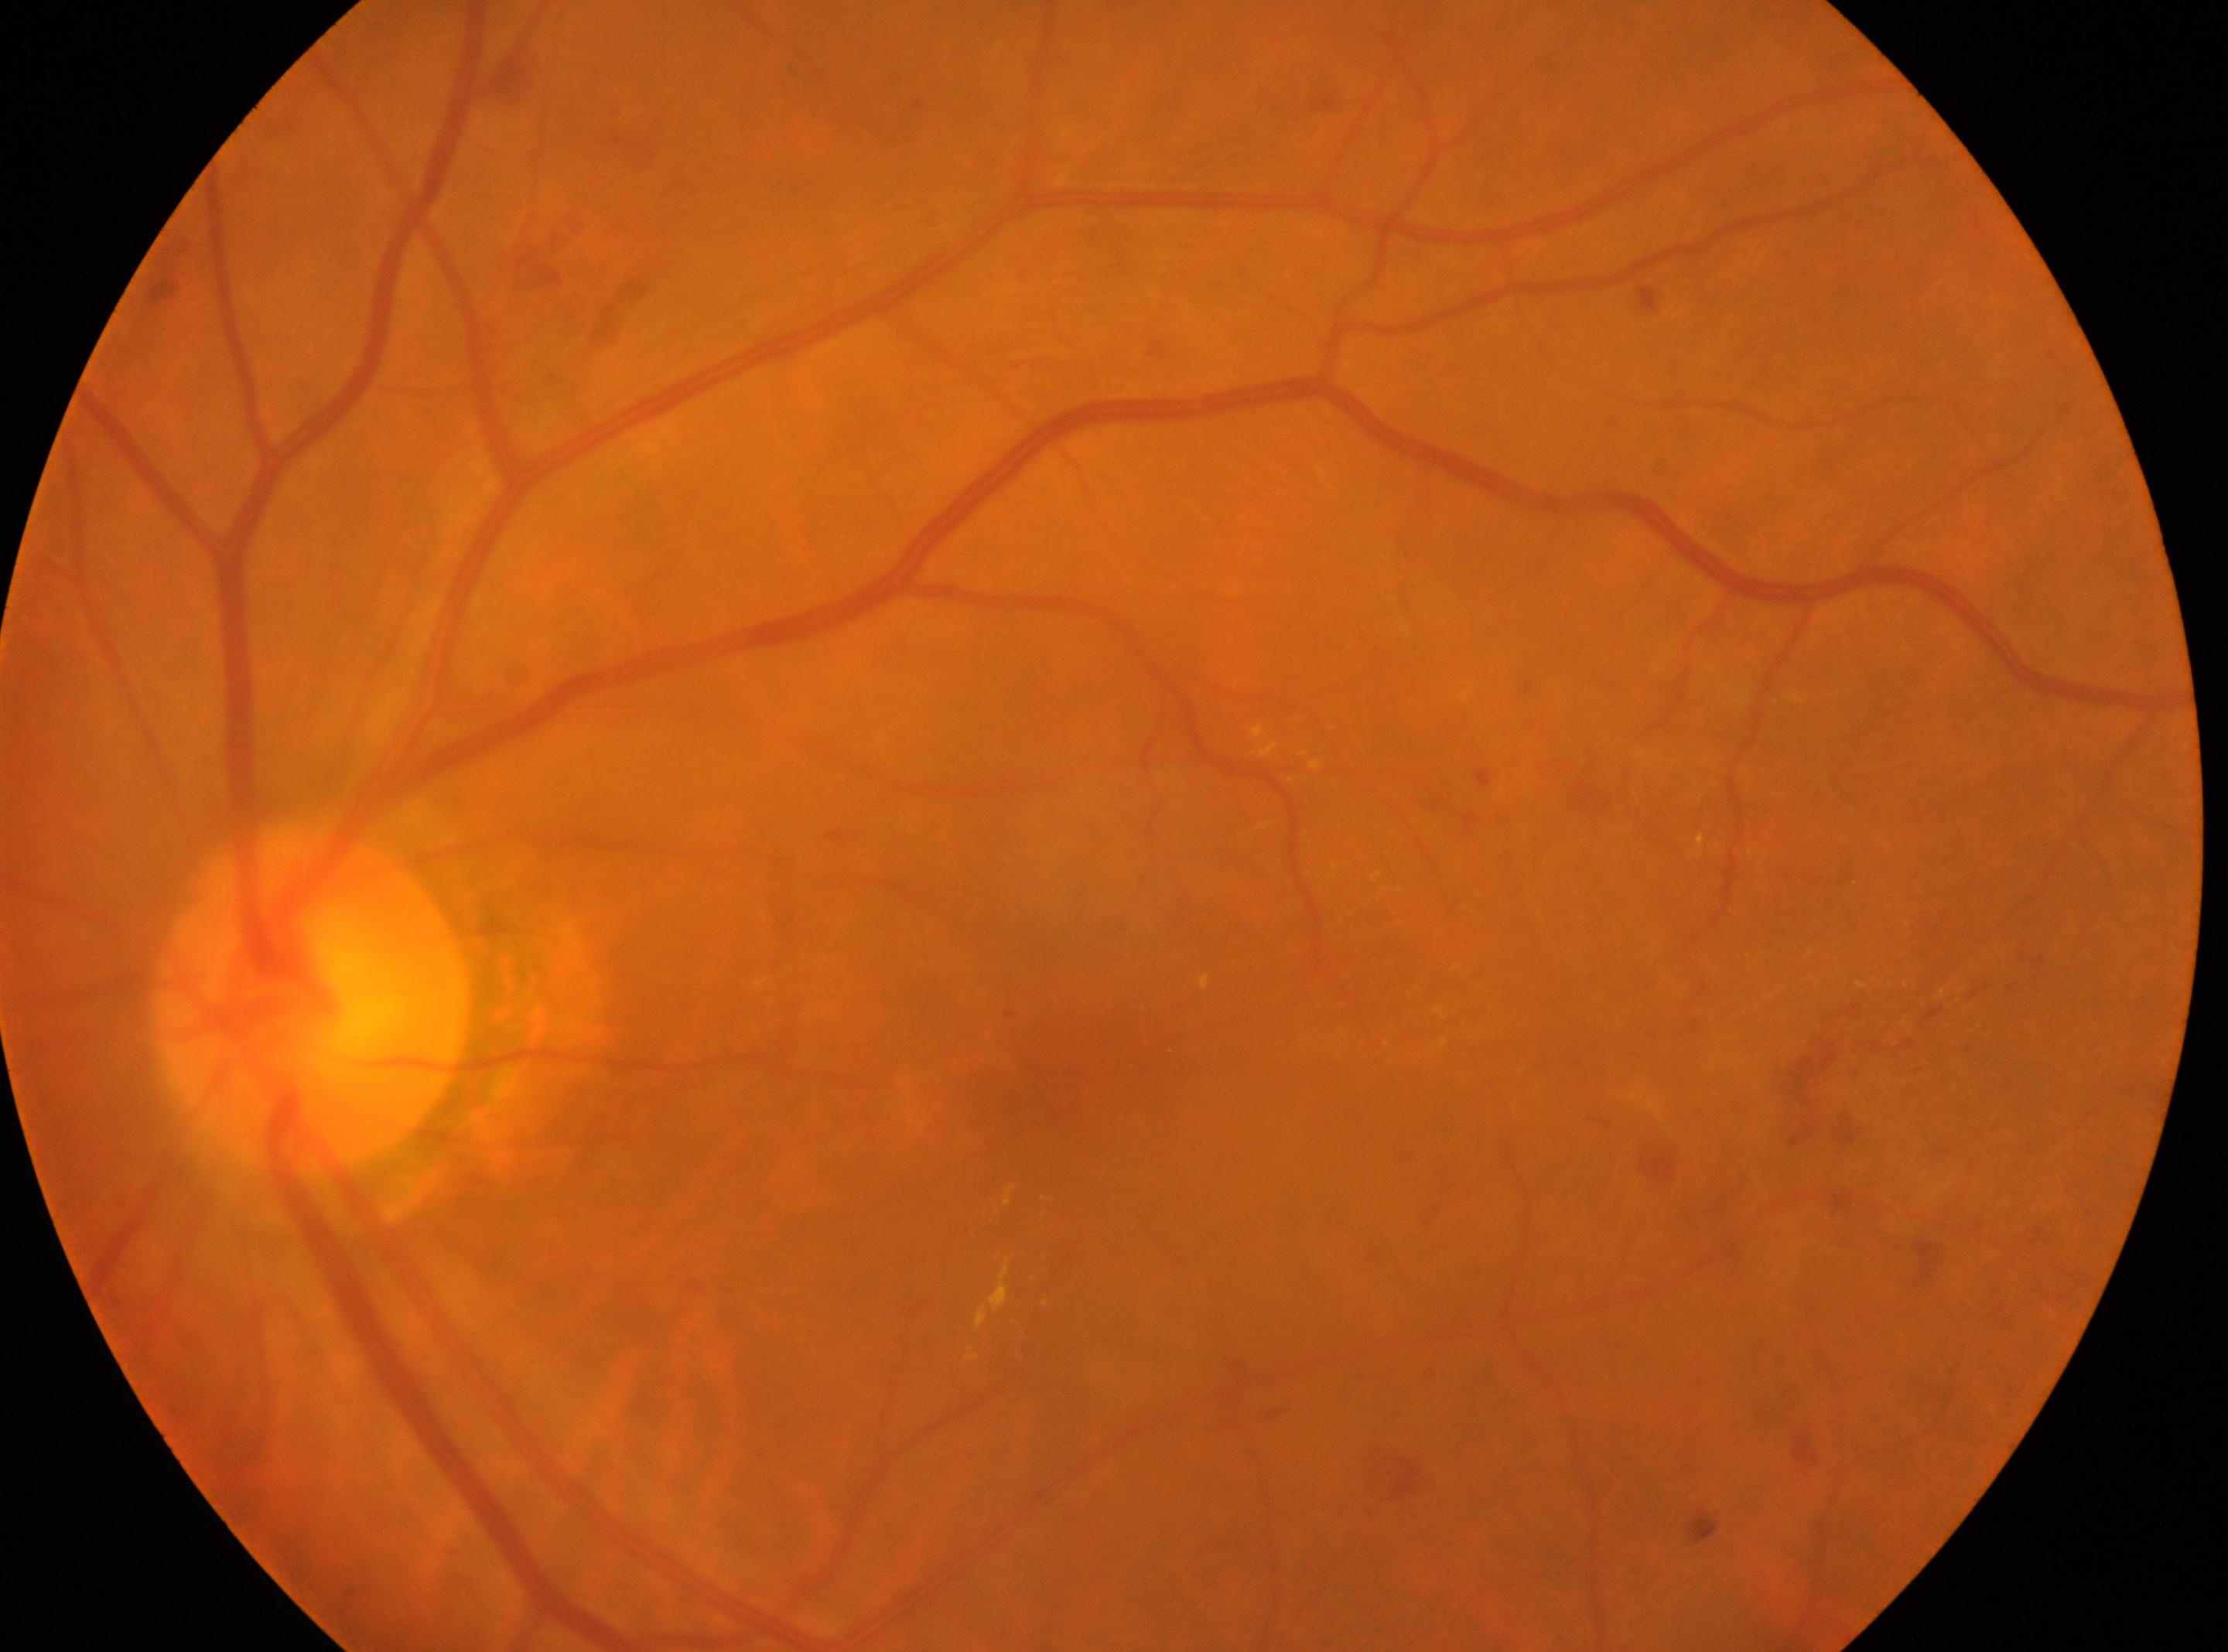 Diabetic retinopathy grade is moderate NPDR (2).
This is the left eye.
The retinopathy is classified as non-proliferative diabetic retinopathy.
Foveal center: (1058,1101).
Optic disc: (308,996).